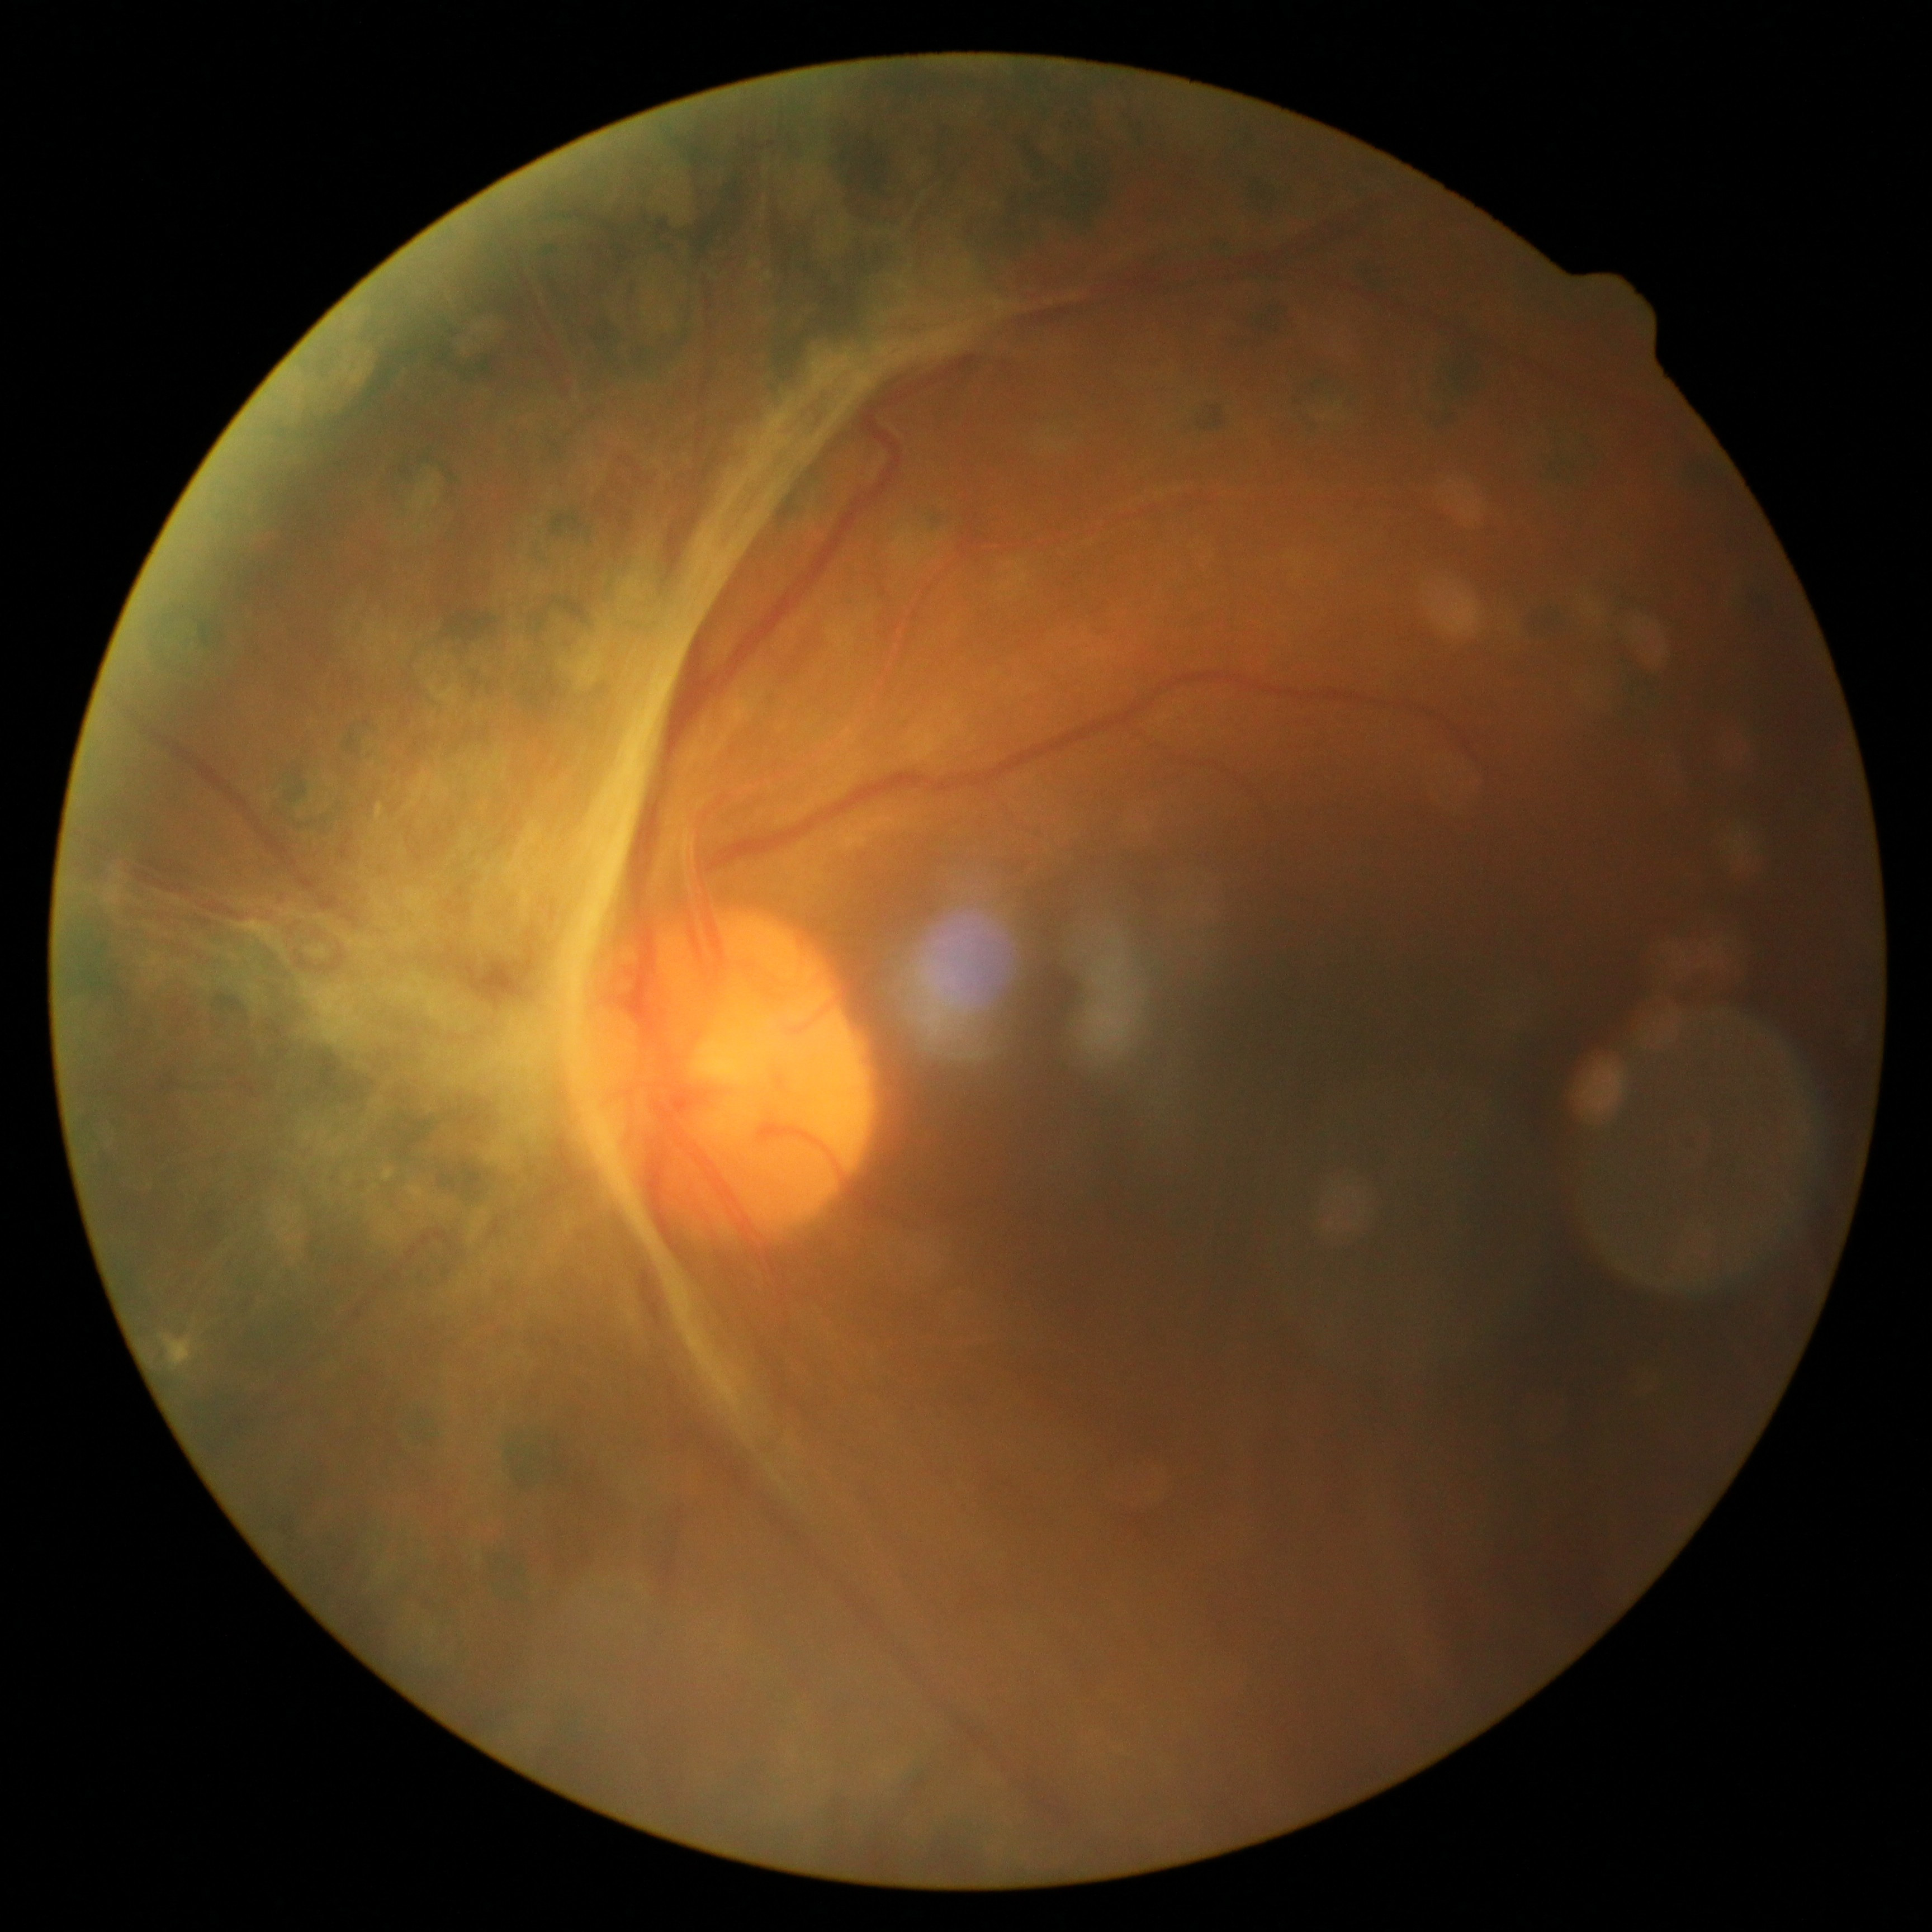 DR is grade 4 (PDR).